Nonmydriatic · color fundus photograph:
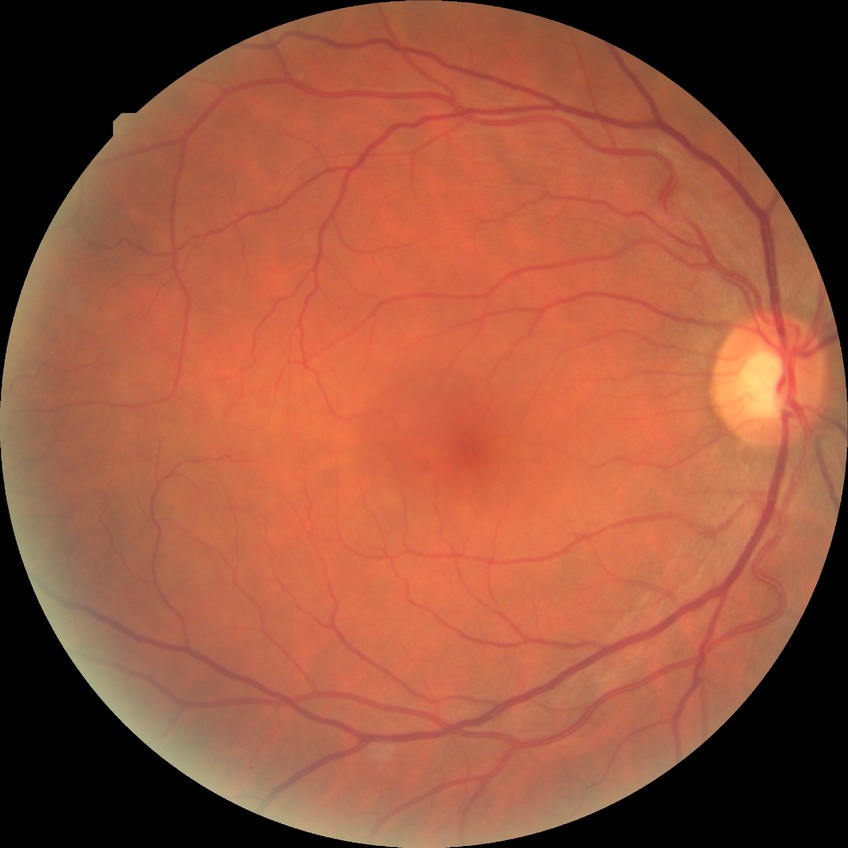

diabetic retinopathy severity: no diabetic retinopathy.